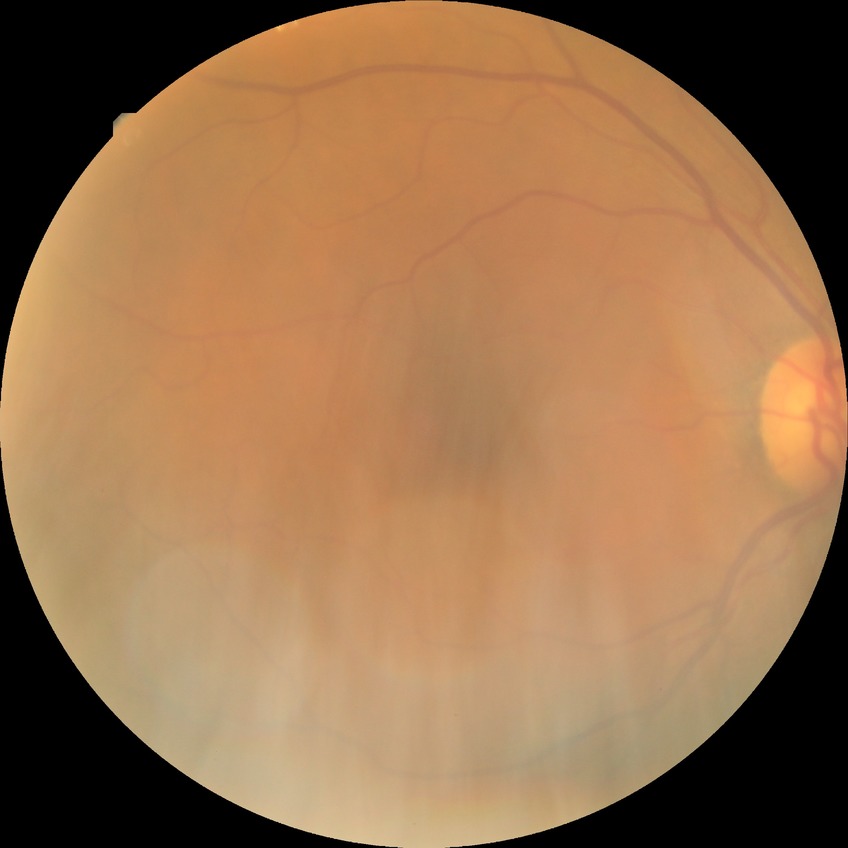 diabetic retinopathy (DR)=no diabetic retinopathy (NDR).